45-degree field of view
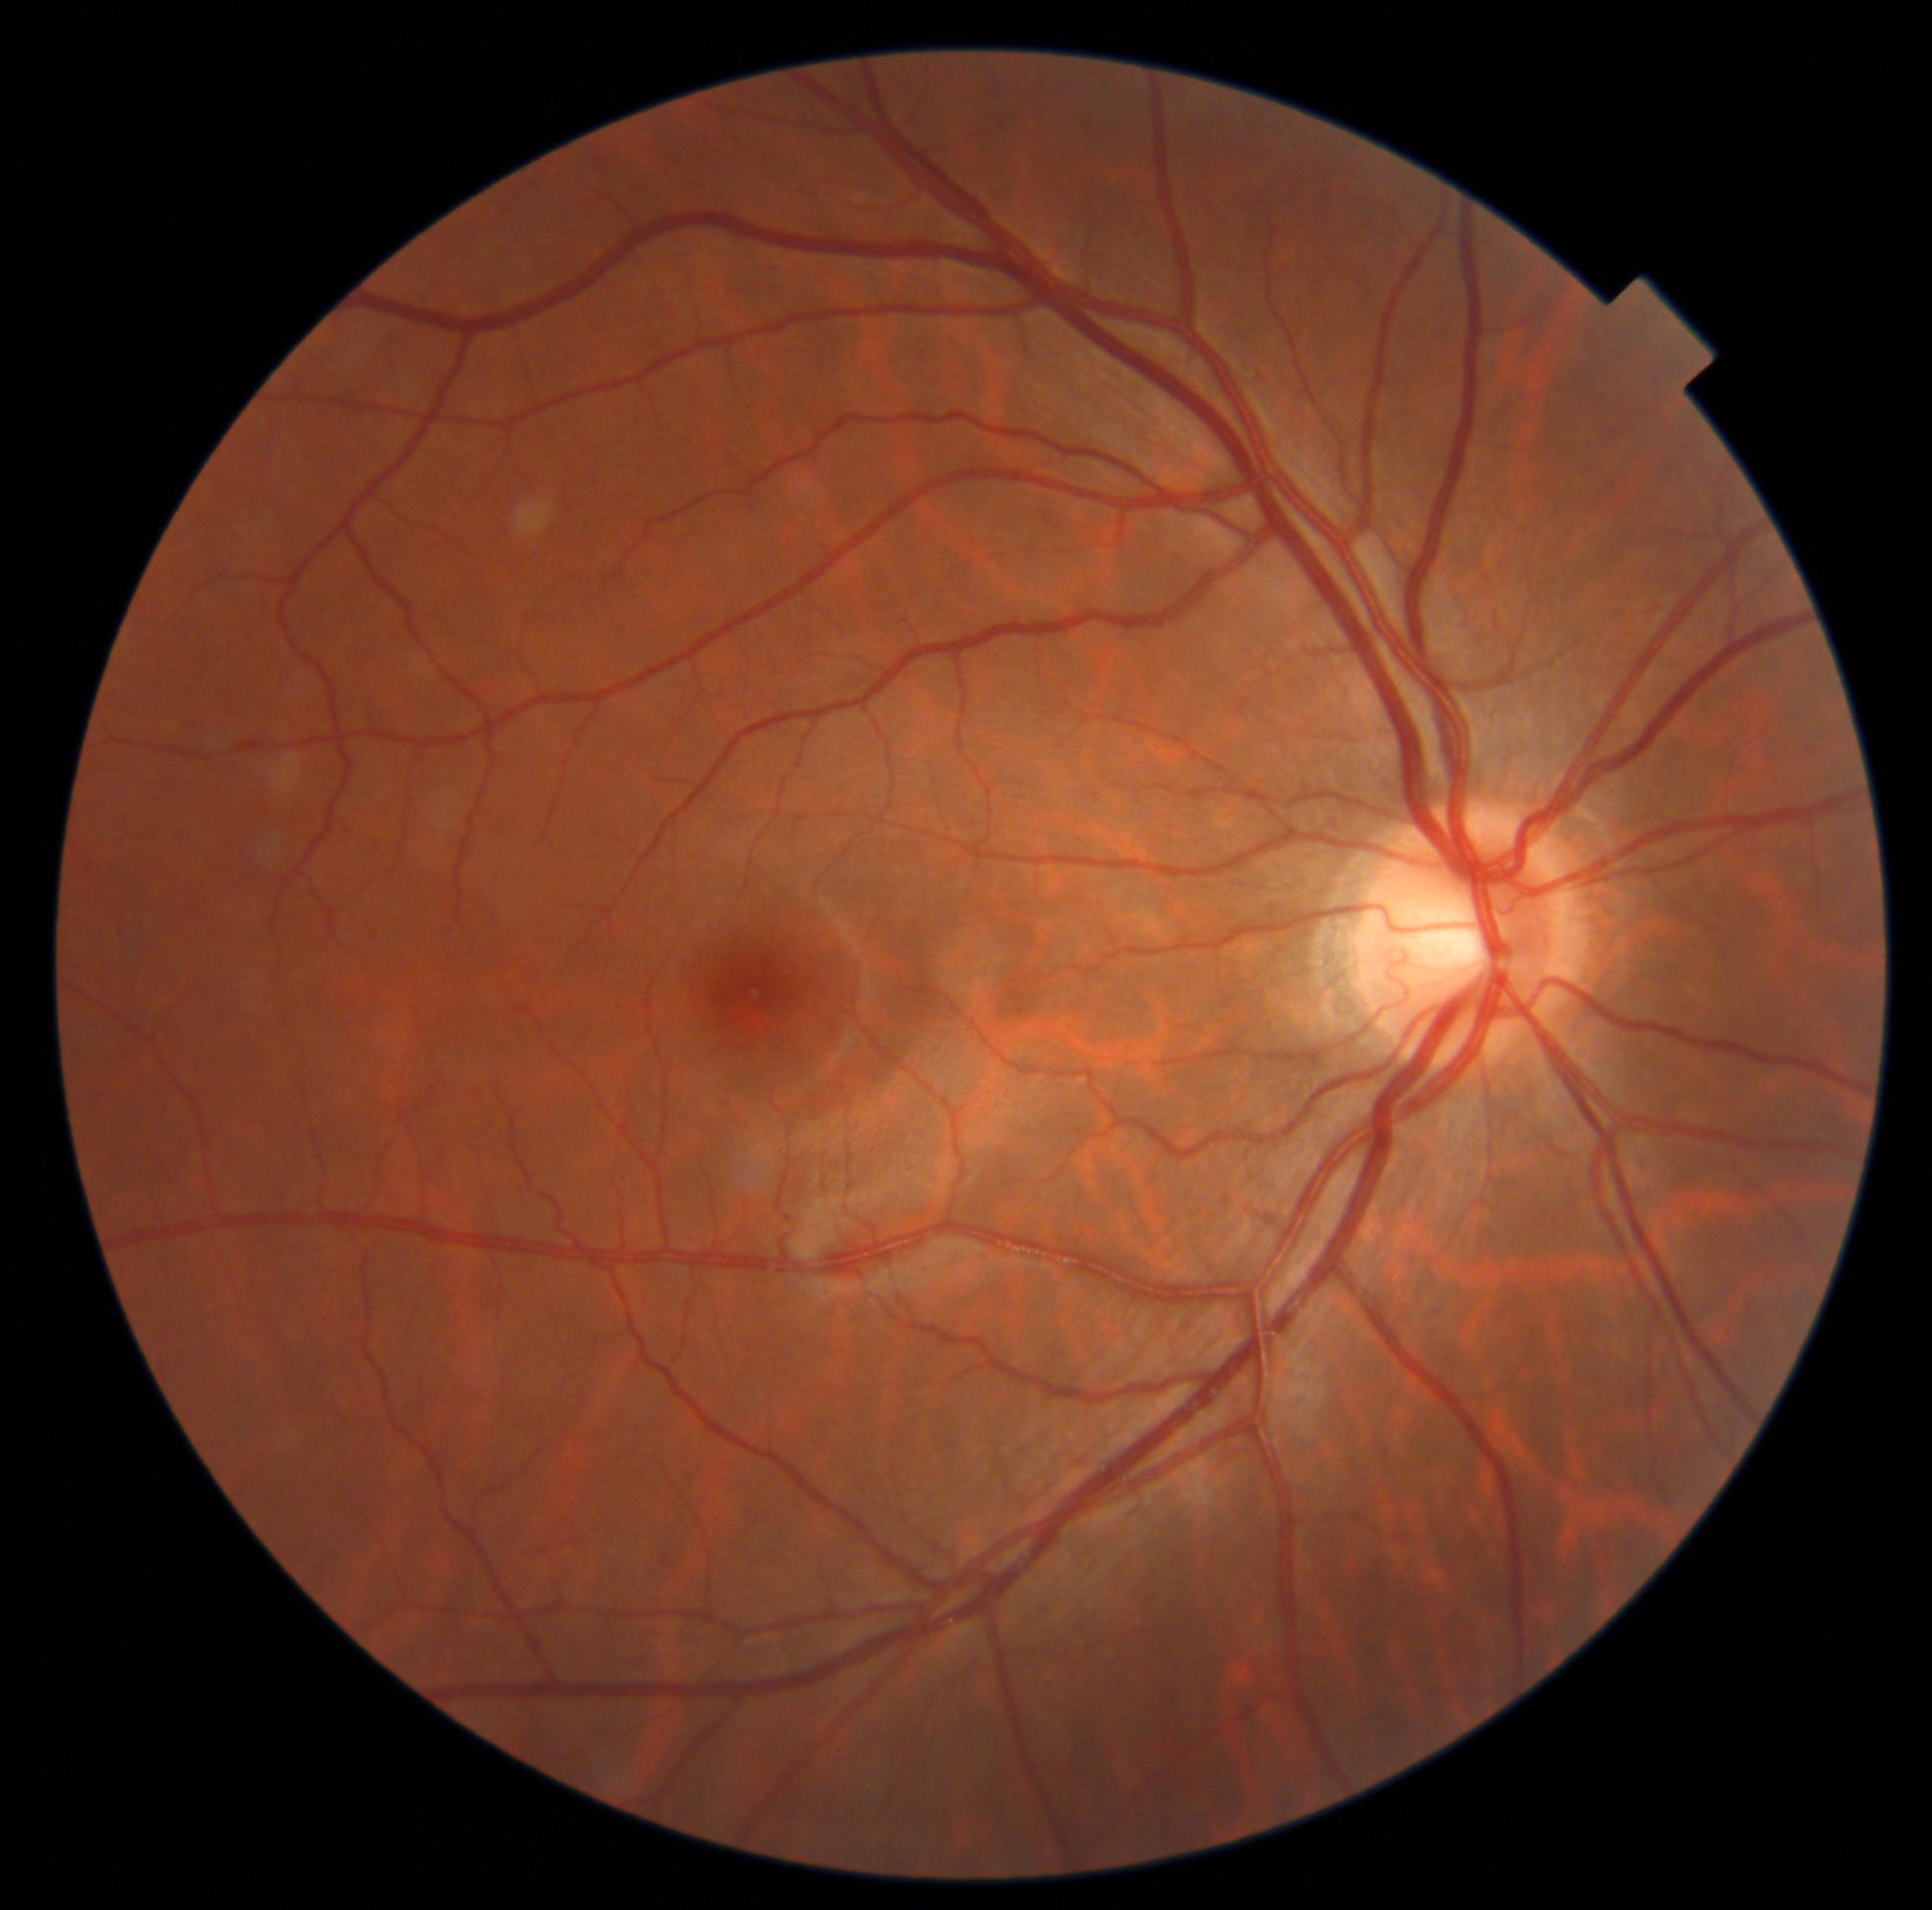
DR severity is no apparent retinopathy (grade 0).